CFP. 512x512px — 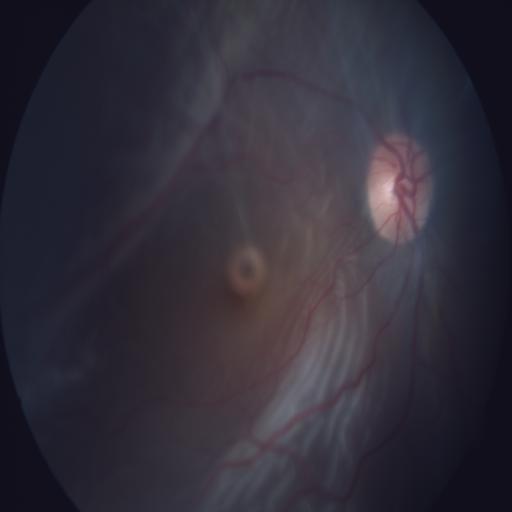

Showing retinal traction.